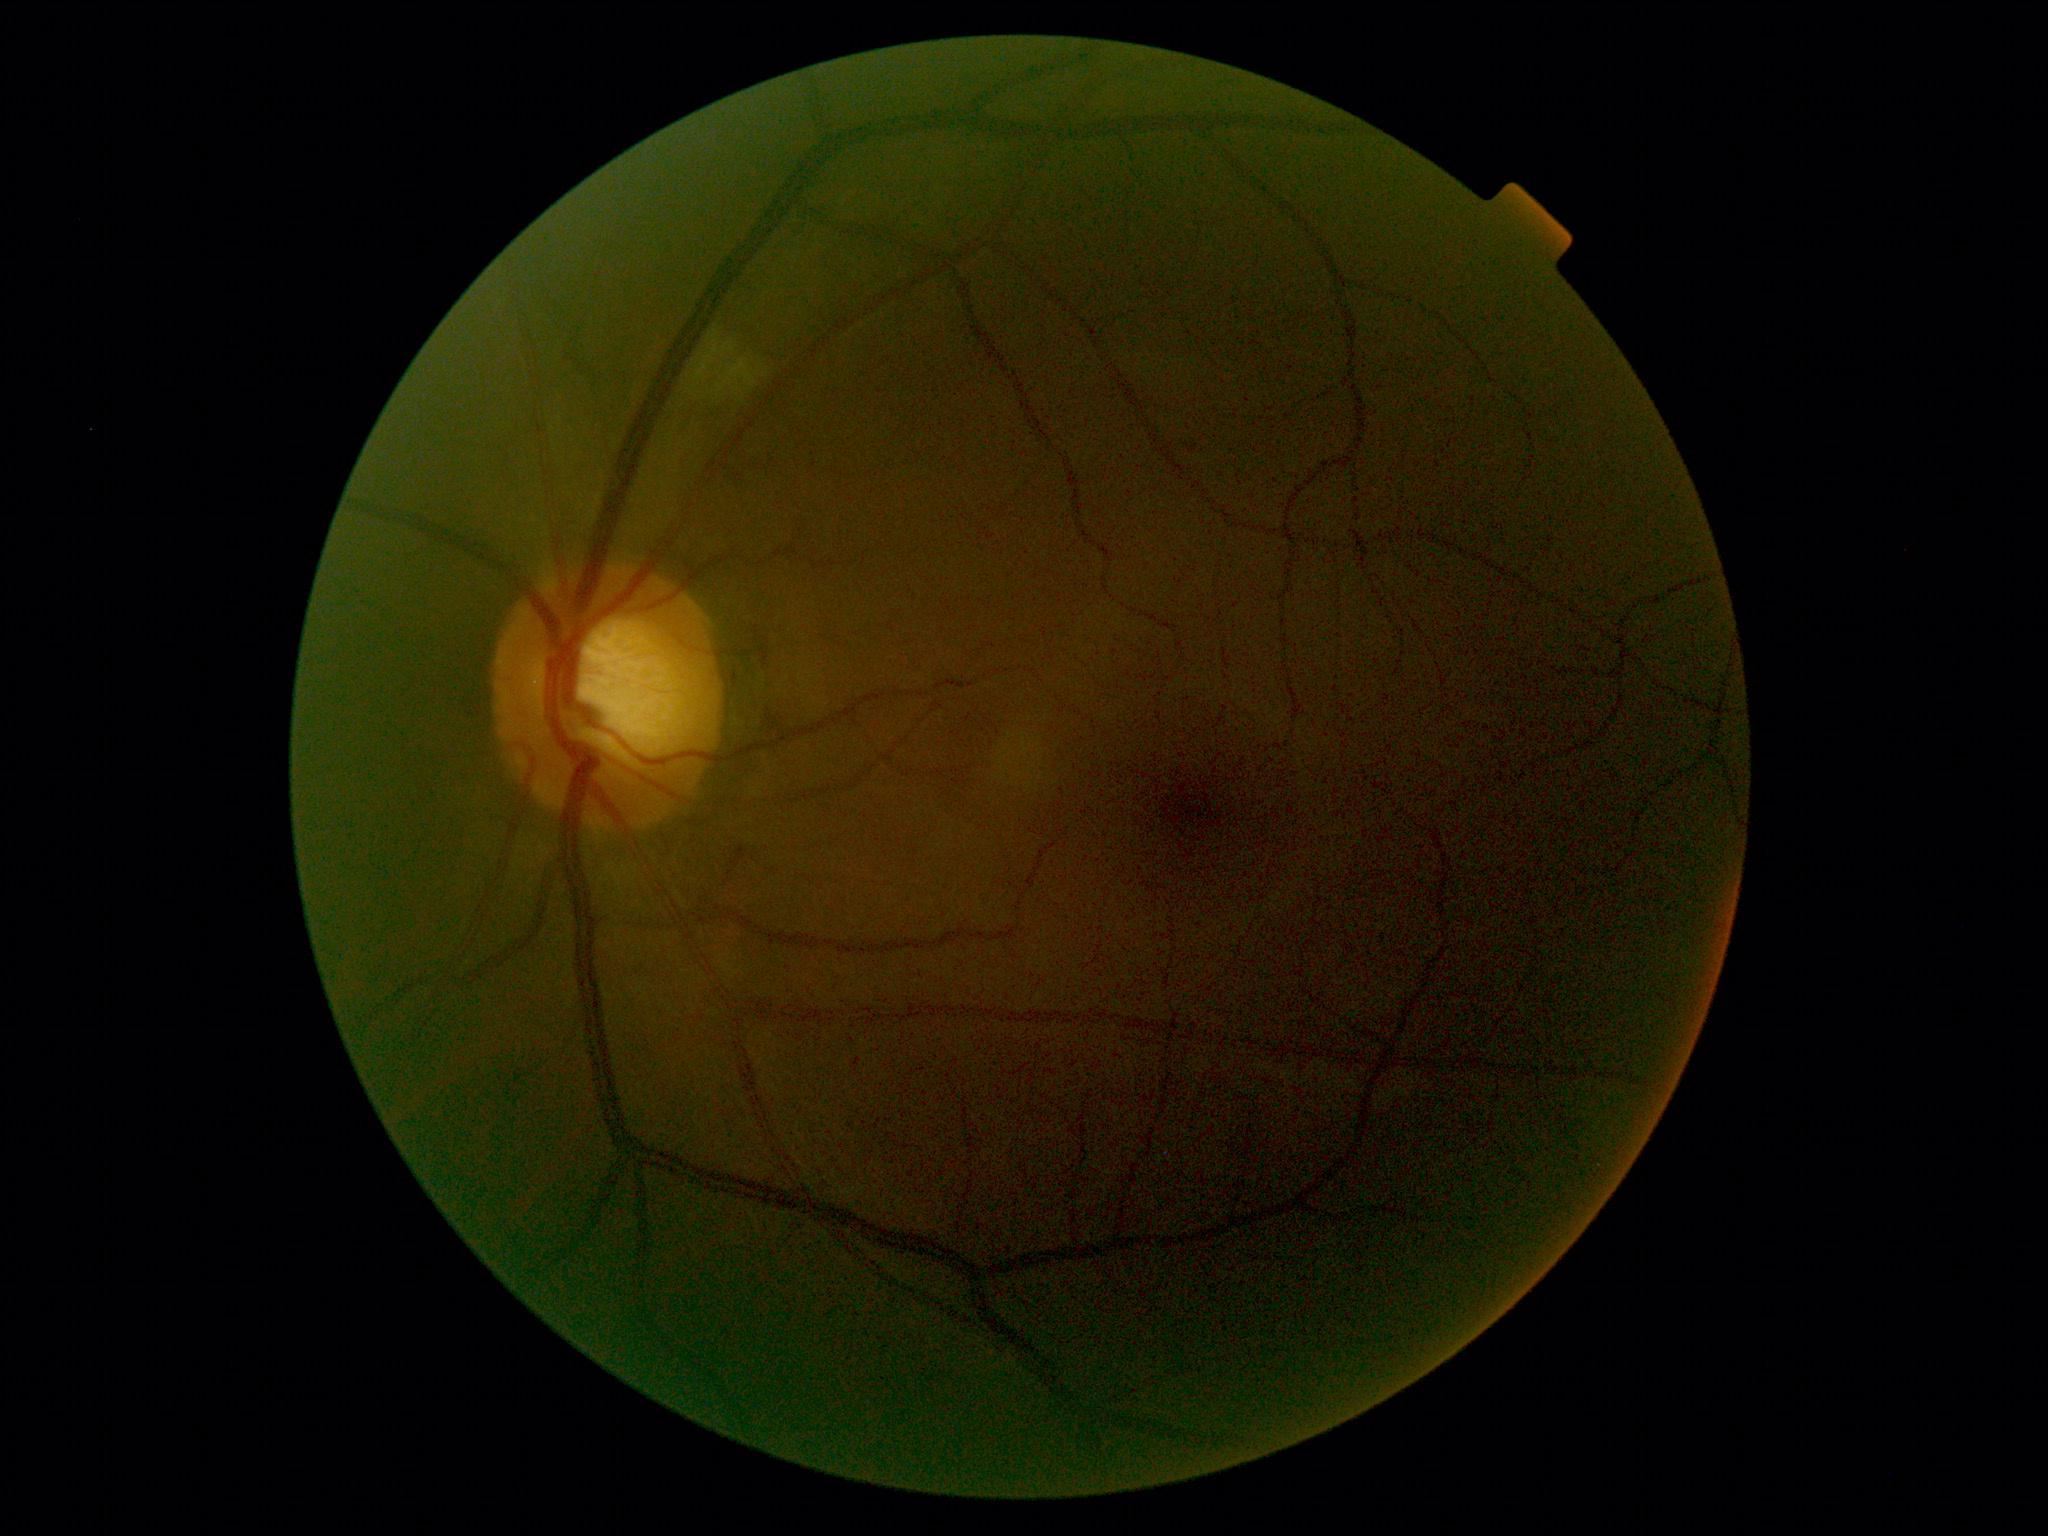 dr_grade: moderate non-proliferative diabetic retinopathy (grade 2)
dr_category: non-proliferative diabetic retinopathy